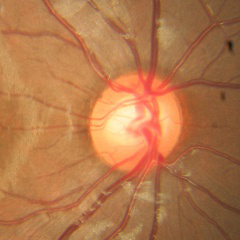
Assessment = no glaucomatous changes.